45° field of view.
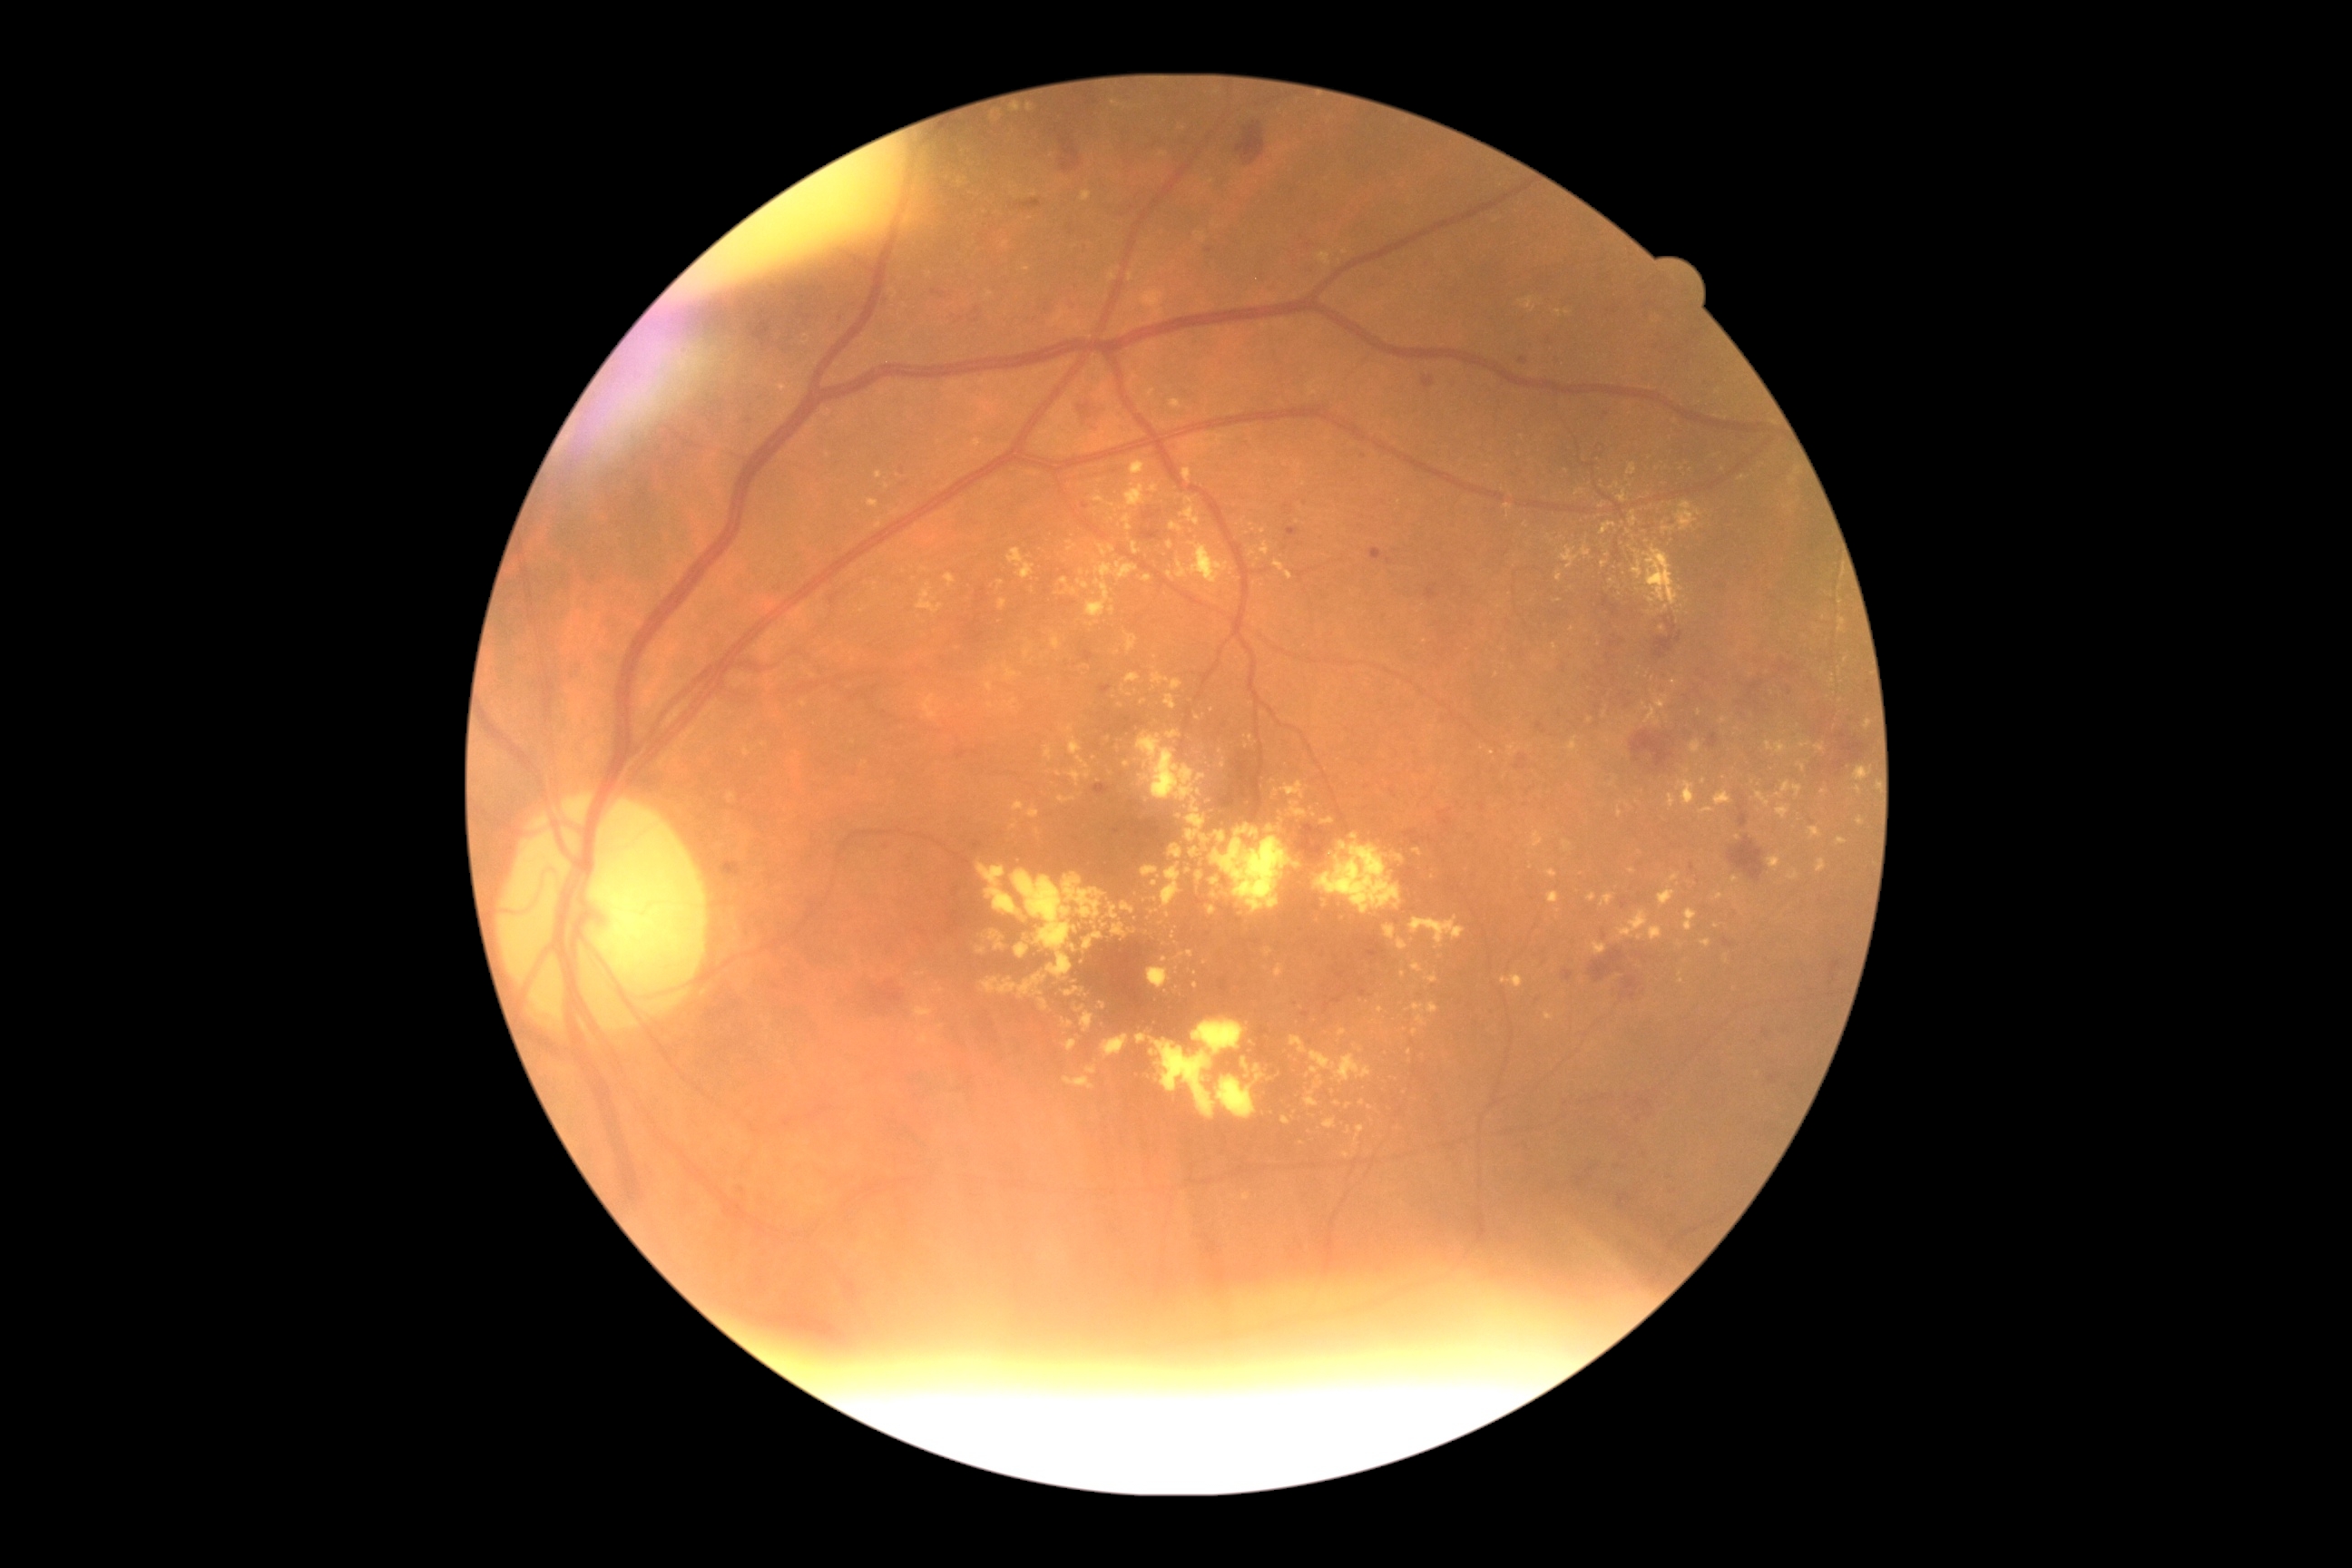
DR stage: moderate NPDR (grade 2). HEs include <region>932, 291, 946, 299</region> | <region>1235, 122, 1266, 166</region> | <region>1081, 651, 1093, 663</region> | <region>1142, 507, 1161, 522</region> | <region>1052, 126, 1061, 135</region> | <region>1631, 732, 1674, 772</region> | <region>1652, 616, 1685, 660</region> | <region>720, 861, 741, 877</region> | <region>1115, 716, 1146, 734</region> | <region>1104, 729, 1113, 734</region> | <region>1763, 1028, 1770, 1039</region> | <region>1093, 783, 1110, 796</region> | <region>1404, 830, 1433, 847</region>. Smaller HEs around x=1645 y=992 | x=1790 y=692 | x=1539 y=1266 | x=748 y=422. EXs include <region>1024, 647, 1032, 660</region> | <region>1012, 870, 1077, 979</region> | <region>1266, 948, 1273, 957</region> | <region>868, 500, 879, 507</region> | <region>1122, 514, 1133, 531</region> | <region>1676, 502, 1703, 531</region> | <region>1505, 504, 1513, 511</region> | <region>1651, 507, 1661, 522</region> | <region>1721, 718, 1729, 723</region> | <region>1112, 925, 1128, 939</region> | <region>1413, 1004, 1426, 1014</region> | <region>1044, 747, 1054, 761</region> | <region>1273, 562, 1293, 580</region>. Smaller EXs around x=1112 y=505 | x=1013 y=195 | x=1348 y=1107 | x=854 y=743 | x=1719 y=393 | x=924 y=570 | x=1273 y=781. MAs include <region>1769, 1075, 1779, 1084</region> | <region>1609, 640, 1625, 649</region> | <region>1369, 549, 1384, 562</region> | <region>1518, 358, 1529, 364</region> | <region>1331, 994, 1346, 1004</region> | <region>1426, 585, 1440, 602</region> | <region>1690, 863, 1696, 872</region> | <region>1536, 723, 1547, 734</region> | <region>1324, 1003, 1331, 1014</region>. Smaller MAs around x=1364 y=457 | x=1363 y=993 | x=1085 y=506 | x=1209 y=252.